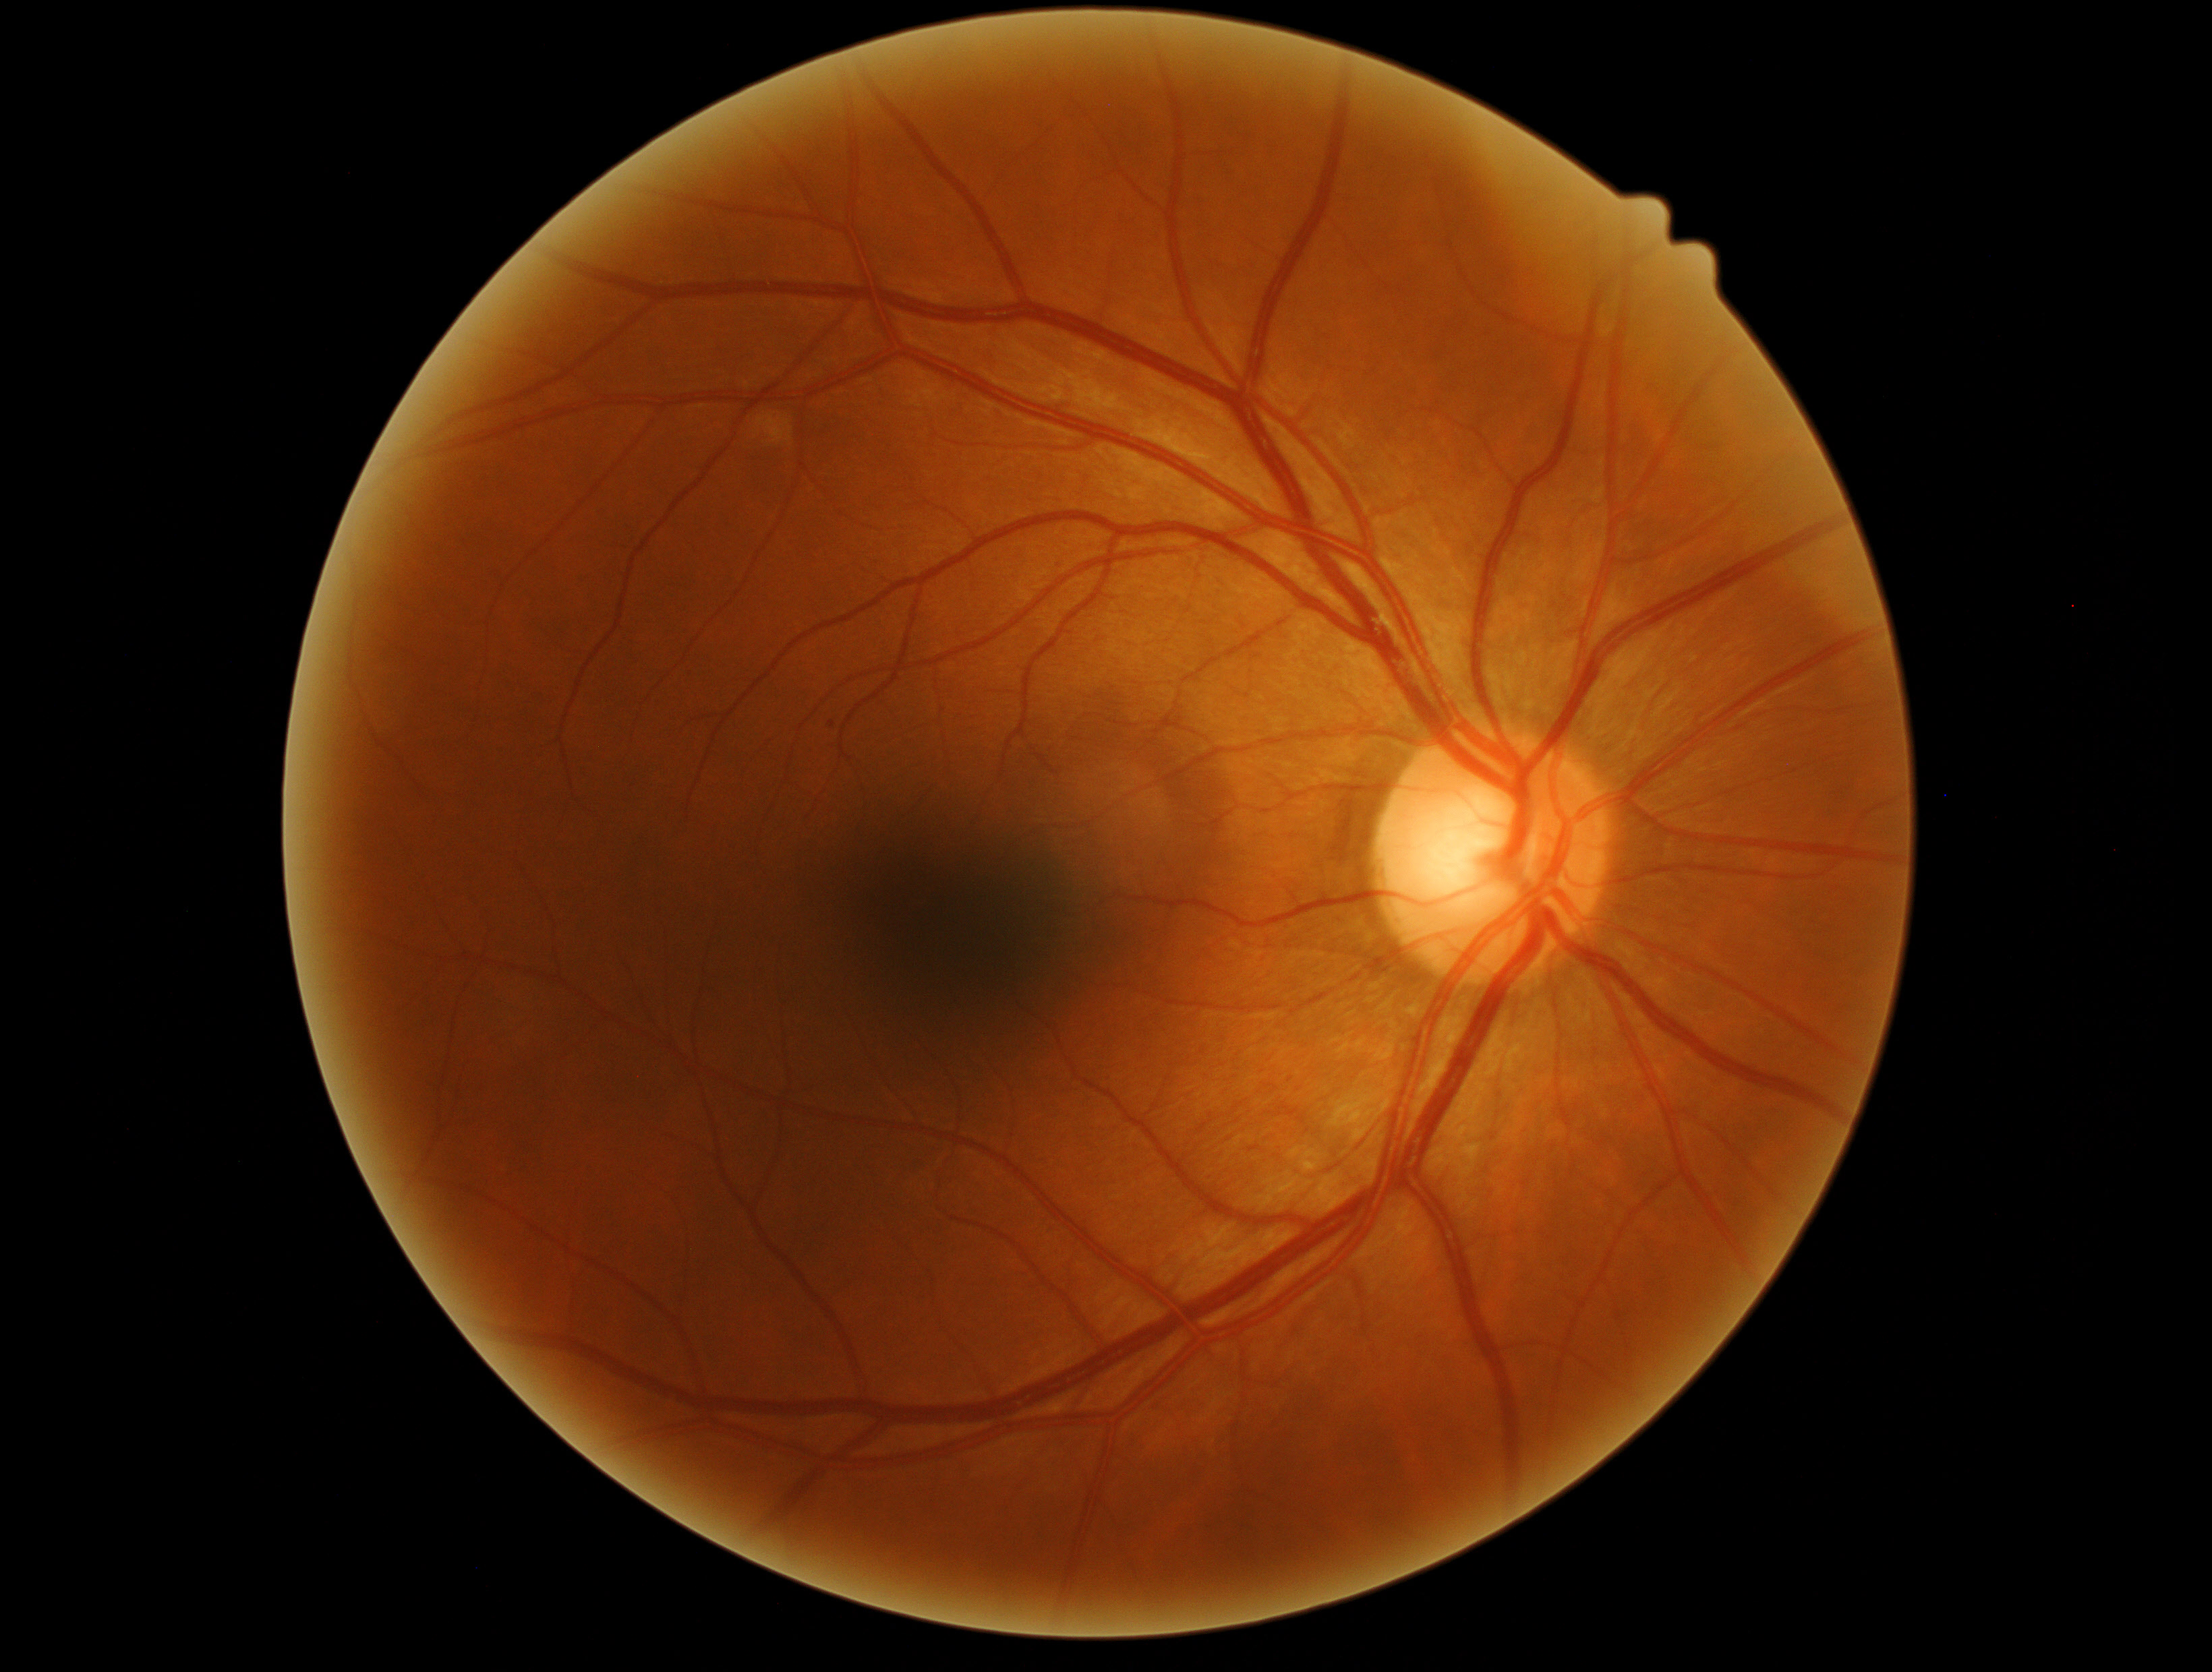 The retinopathy is classified as non-proliferative diabetic retinopathy.
DR stage is 1.